Image size 1240x1240; Phoenix ICON wide-field infant fundus image: 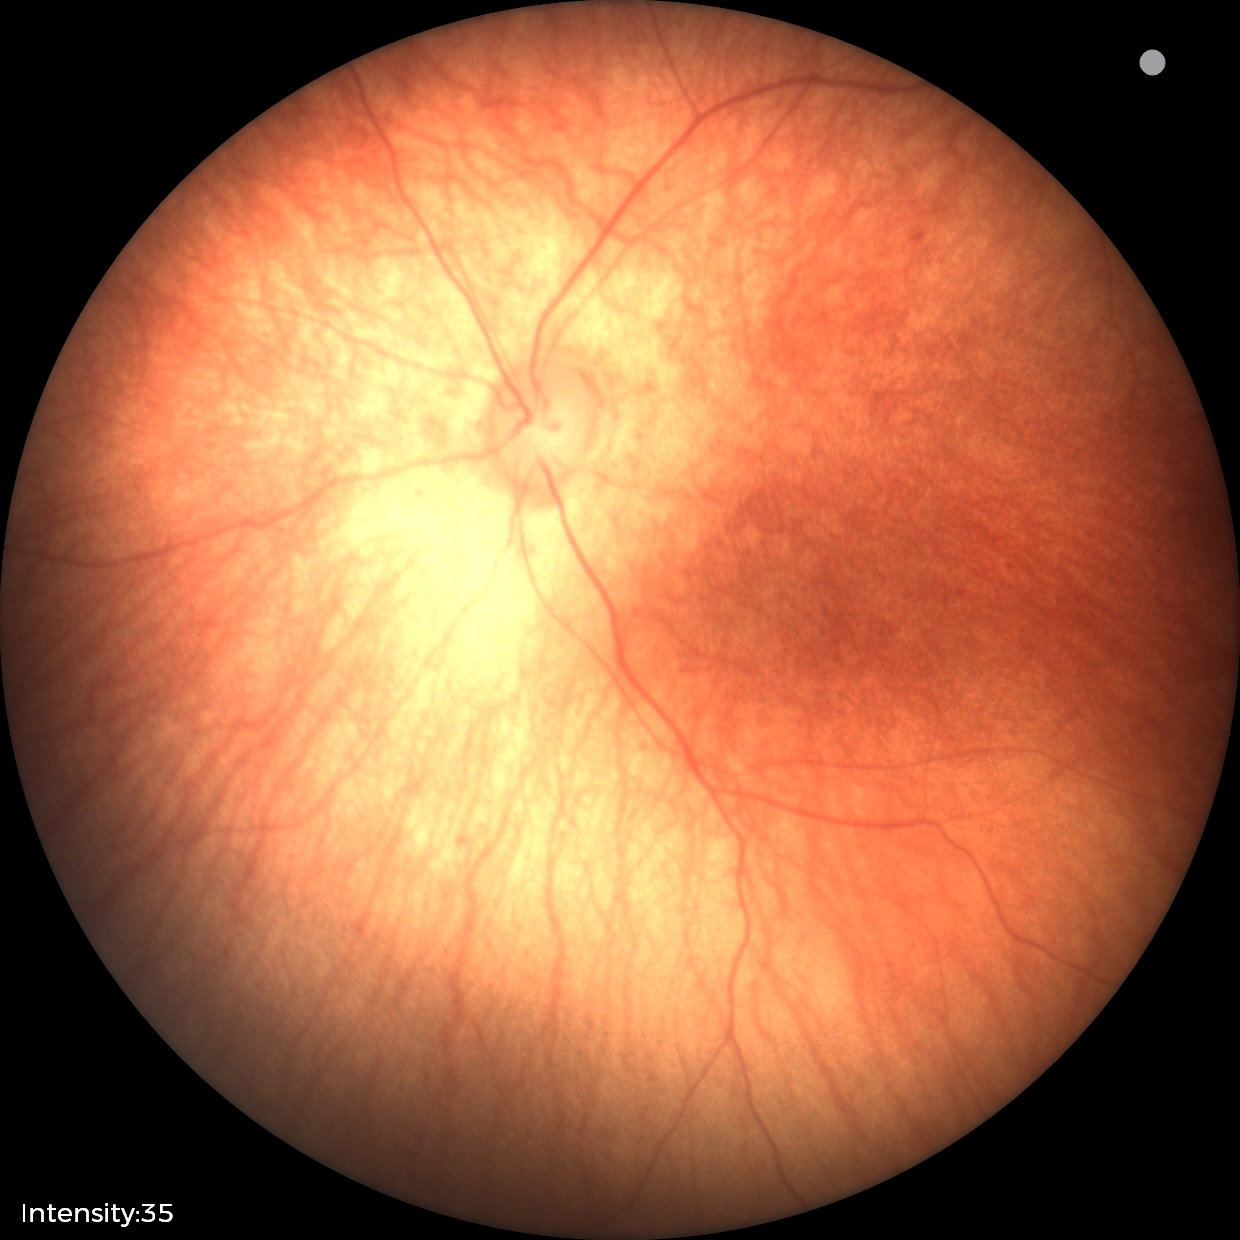

Physiological retinal appearance for postconceptual age.